240 by 240 pixels, CFP: 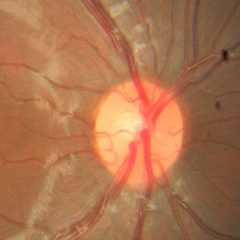
Glaucoma stage = no glaucomatous changes.